1932 by 1916 pixels · FOV: 45 degrees: 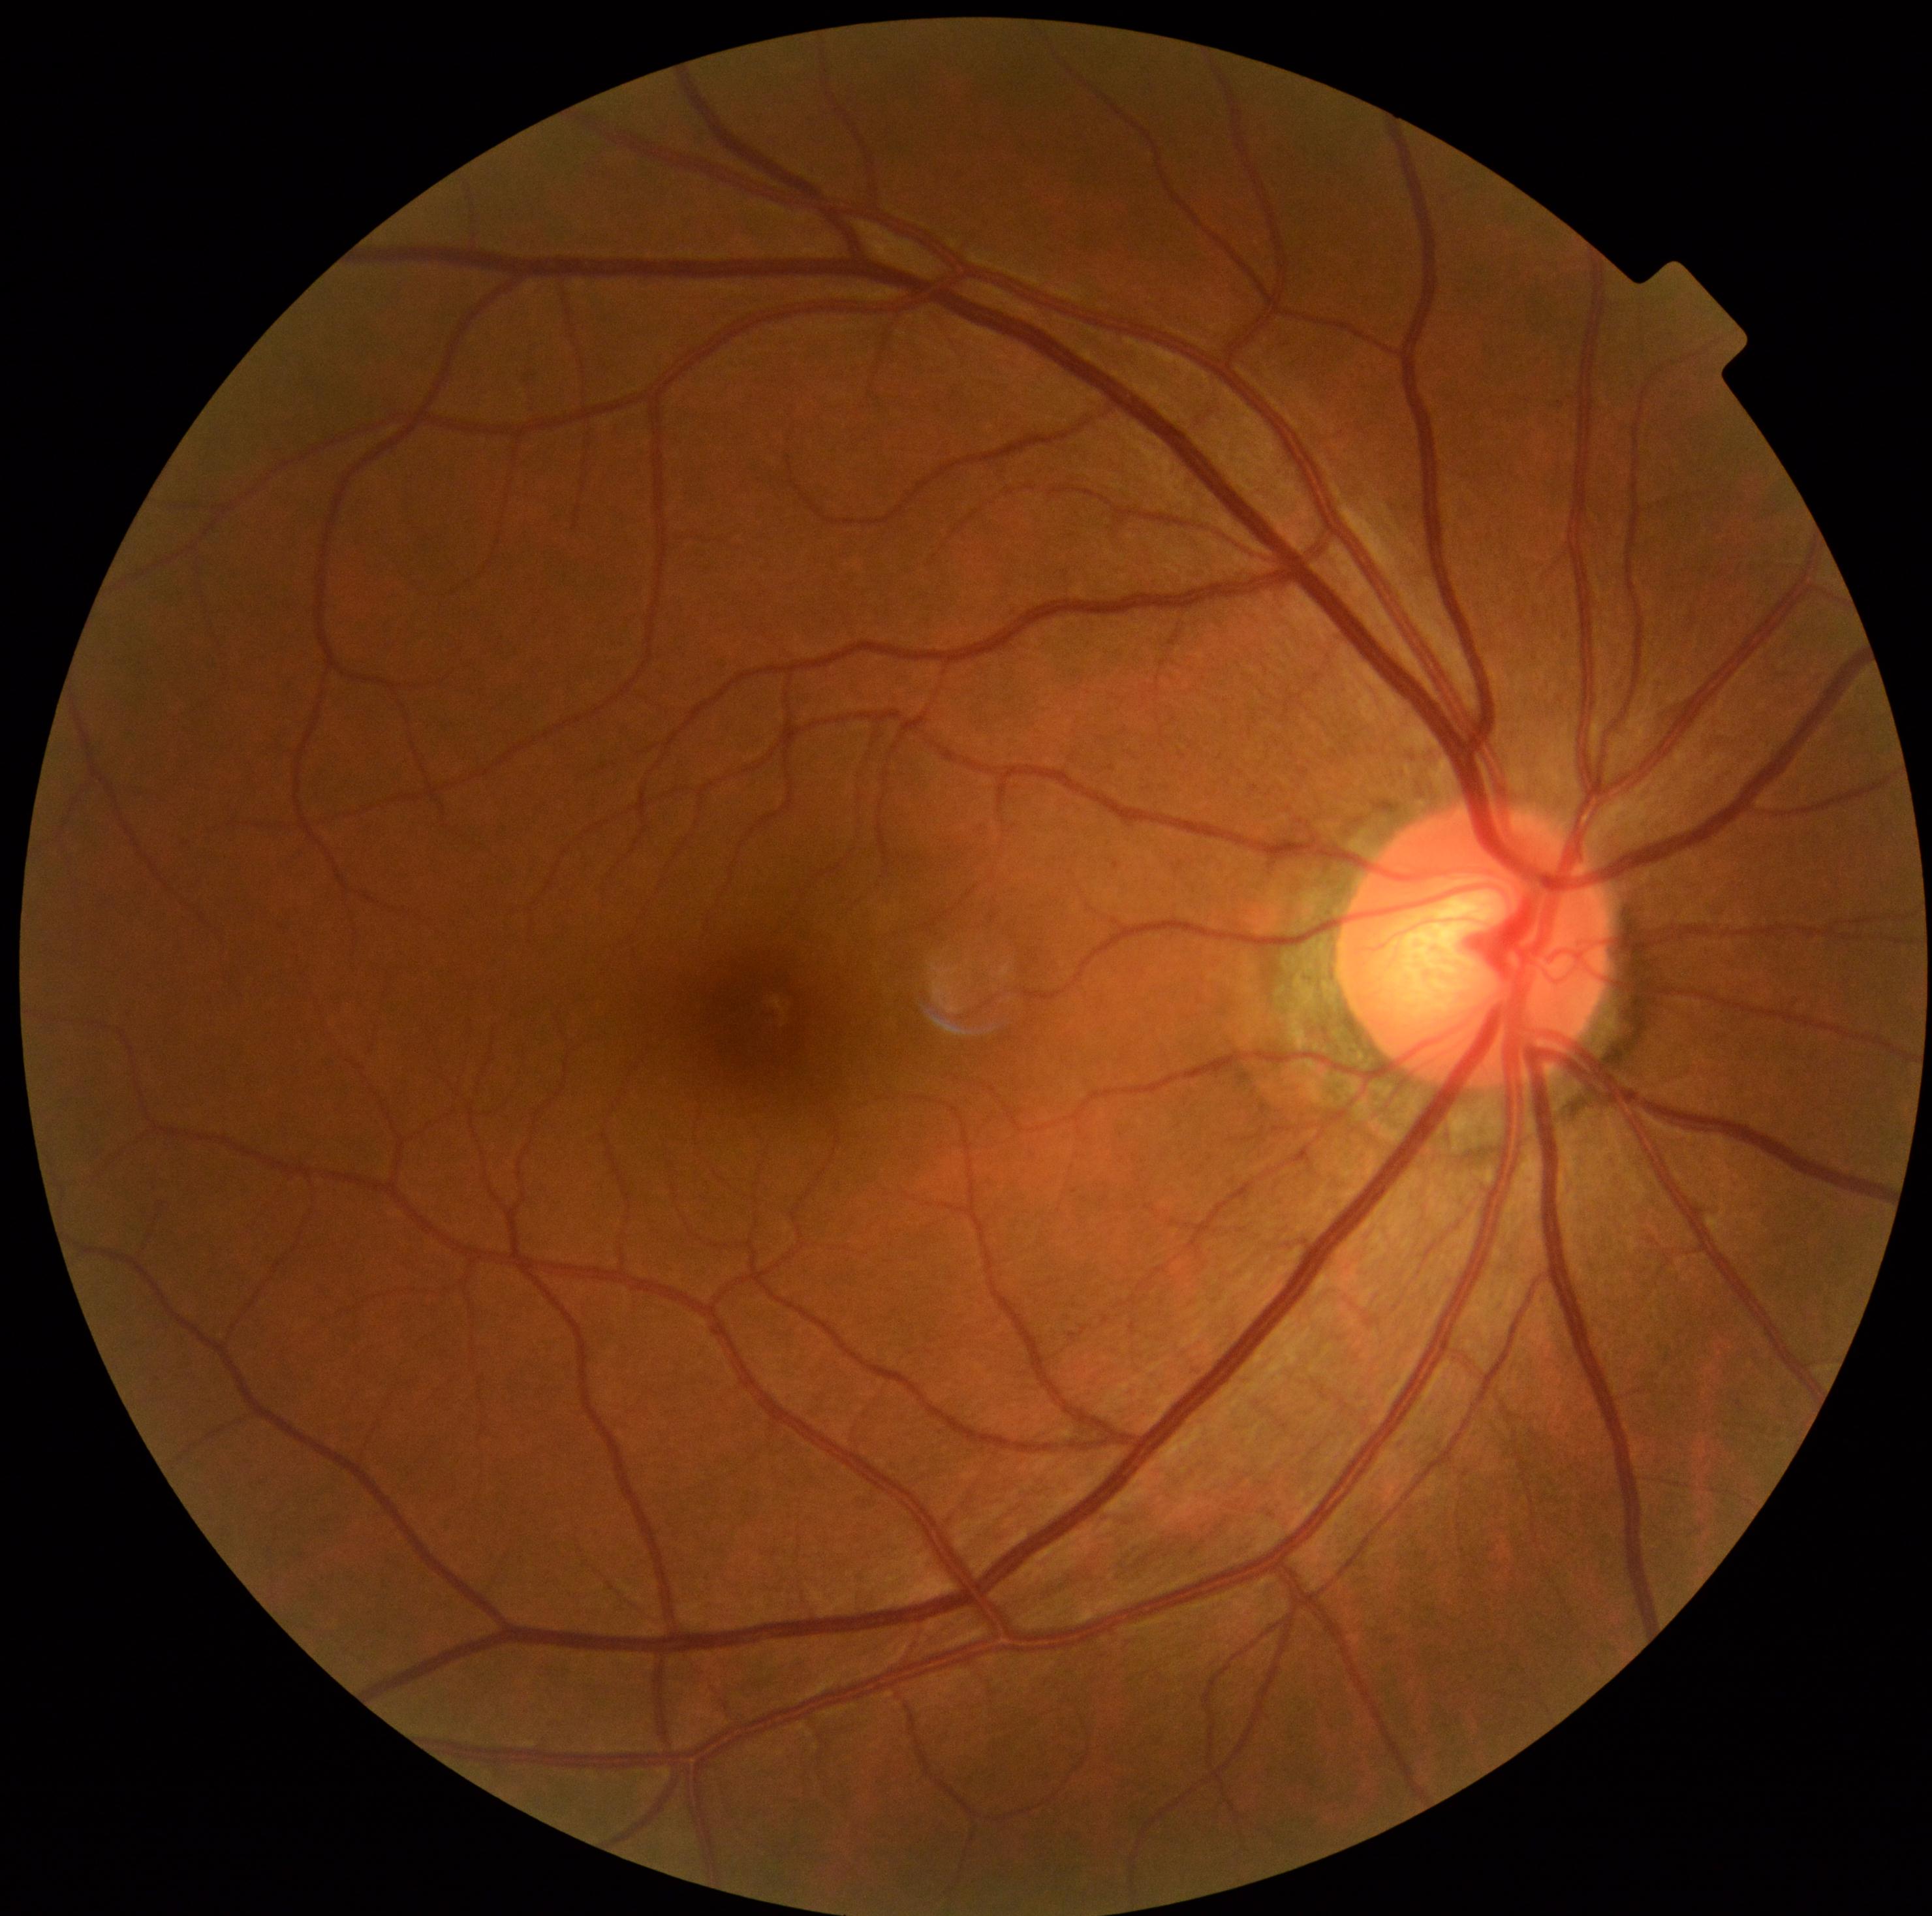

No signs of diabetic retinopathy.
Diabetic retinopathy (DR) is no apparent diabetic retinopathy (grade 0).